1624x1232
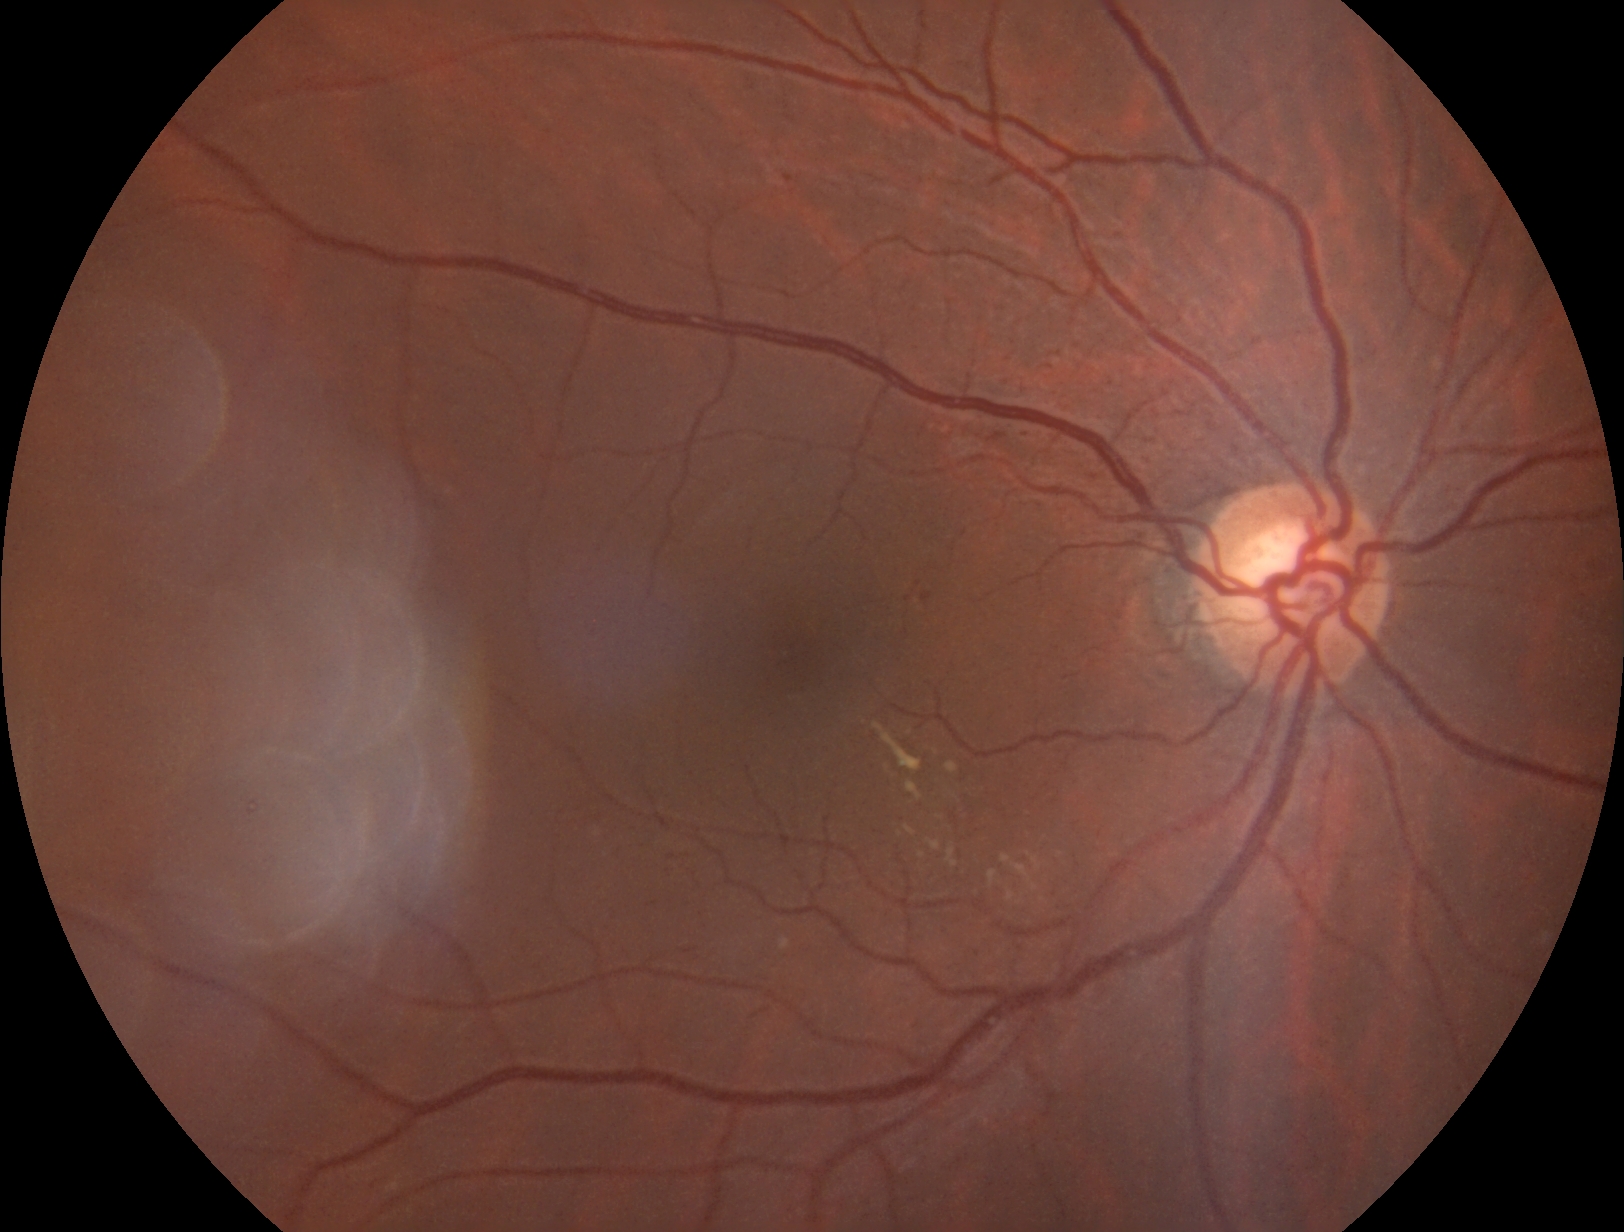 Diabetic retinopathy severity: grade 2 — more than just microaneurysms but less than severe NPDR.